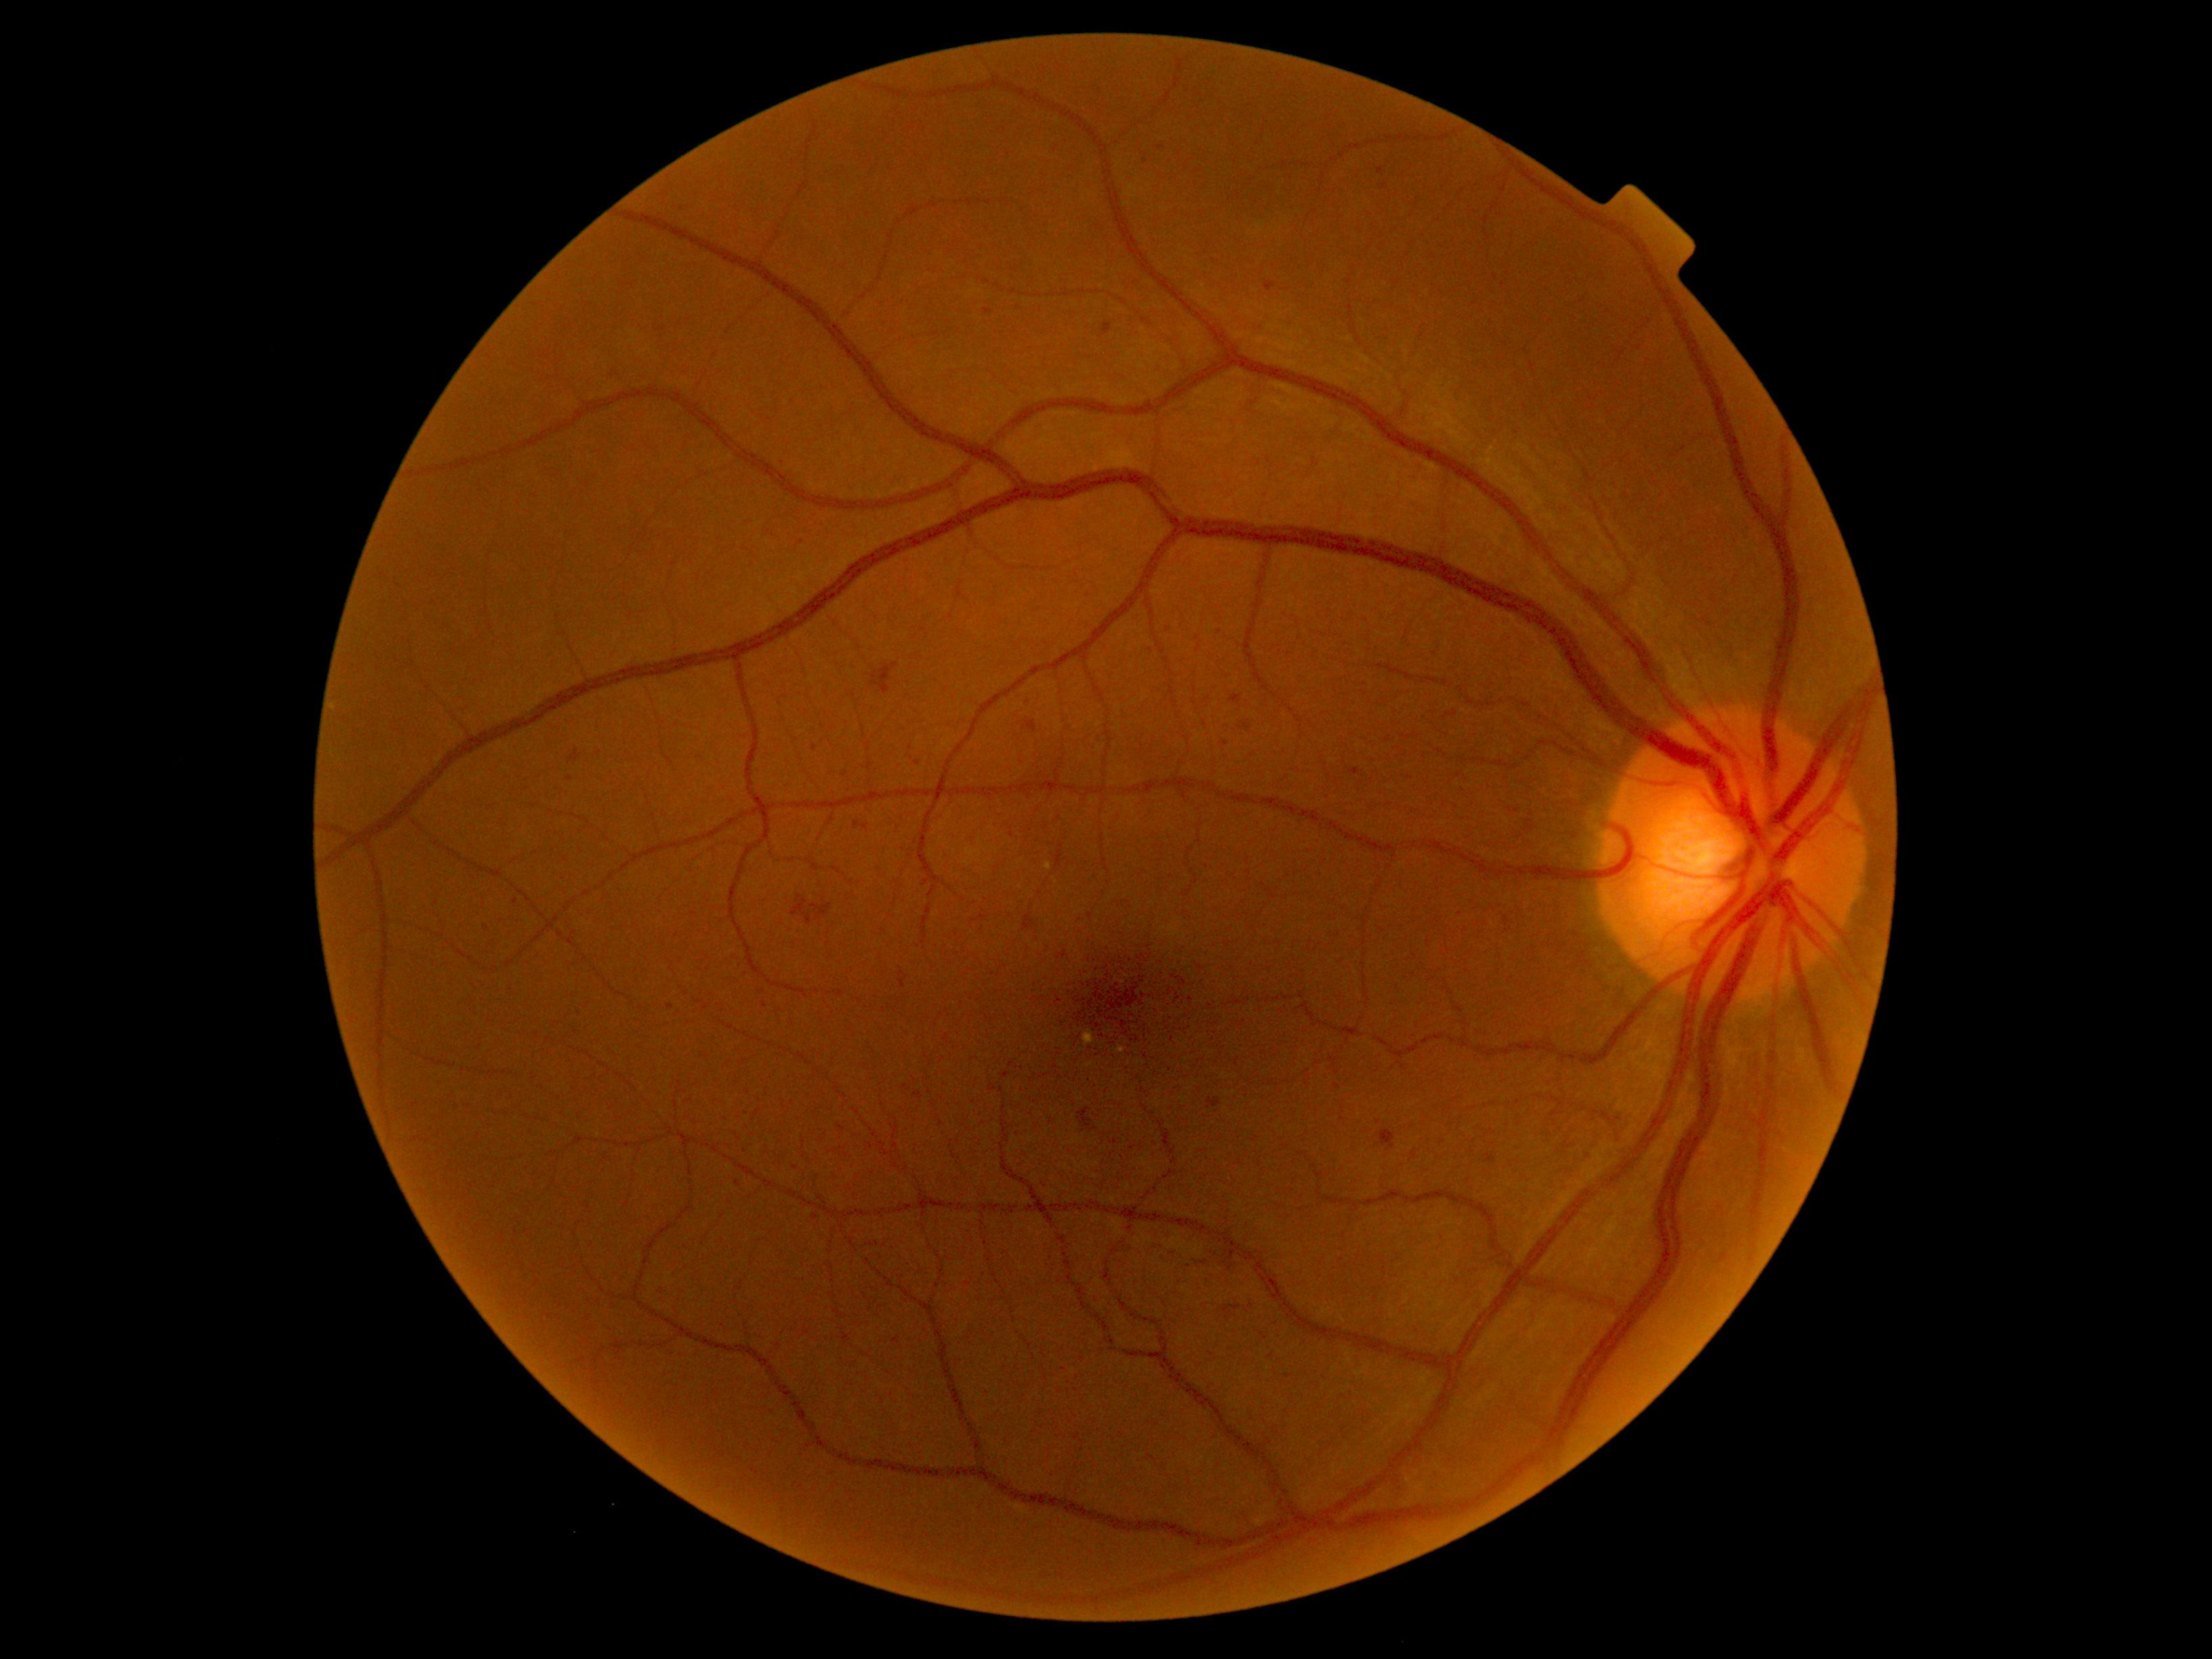
Diabetic retinopathy (DR) is grade 2; non-proliferative diabetic retinopathy.
Hard exudates (EXs) are located at <box>1084,1029,1094,1047</box>; <box>1118,1047,1126,1054</box>; <box>1044,863,1052,871</box>.
Hemorrhages (HEs) include <box>1240,722,1249,729</box>; <box>1229,695,1241,705</box>; <box>1380,184,1389,189</box>; <box>779,462,788,470</box>; <box>913,1090,922,1100</box>; <box>609,371,626,386</box>; <box>837,1126,845,1131</box>; <box>871,663,899,695</box>; <box>1265,283,1277,292</box>; <box>1379,1131,1397,1149</box>; <box>1023,720,1038,733</box>.
Additional small HEs near [x=726, y=1119]; [x=671, y=1007]; [x=911, y=748]; [x=770, y=420]; [x=801, y=542]; [x=1225, y=743]; [x=1161, y=148]; [x=846, y=774]; [x=515, y=902].
No soft exudates (SEs) identified.
No microaneurysms (MAs) identified.